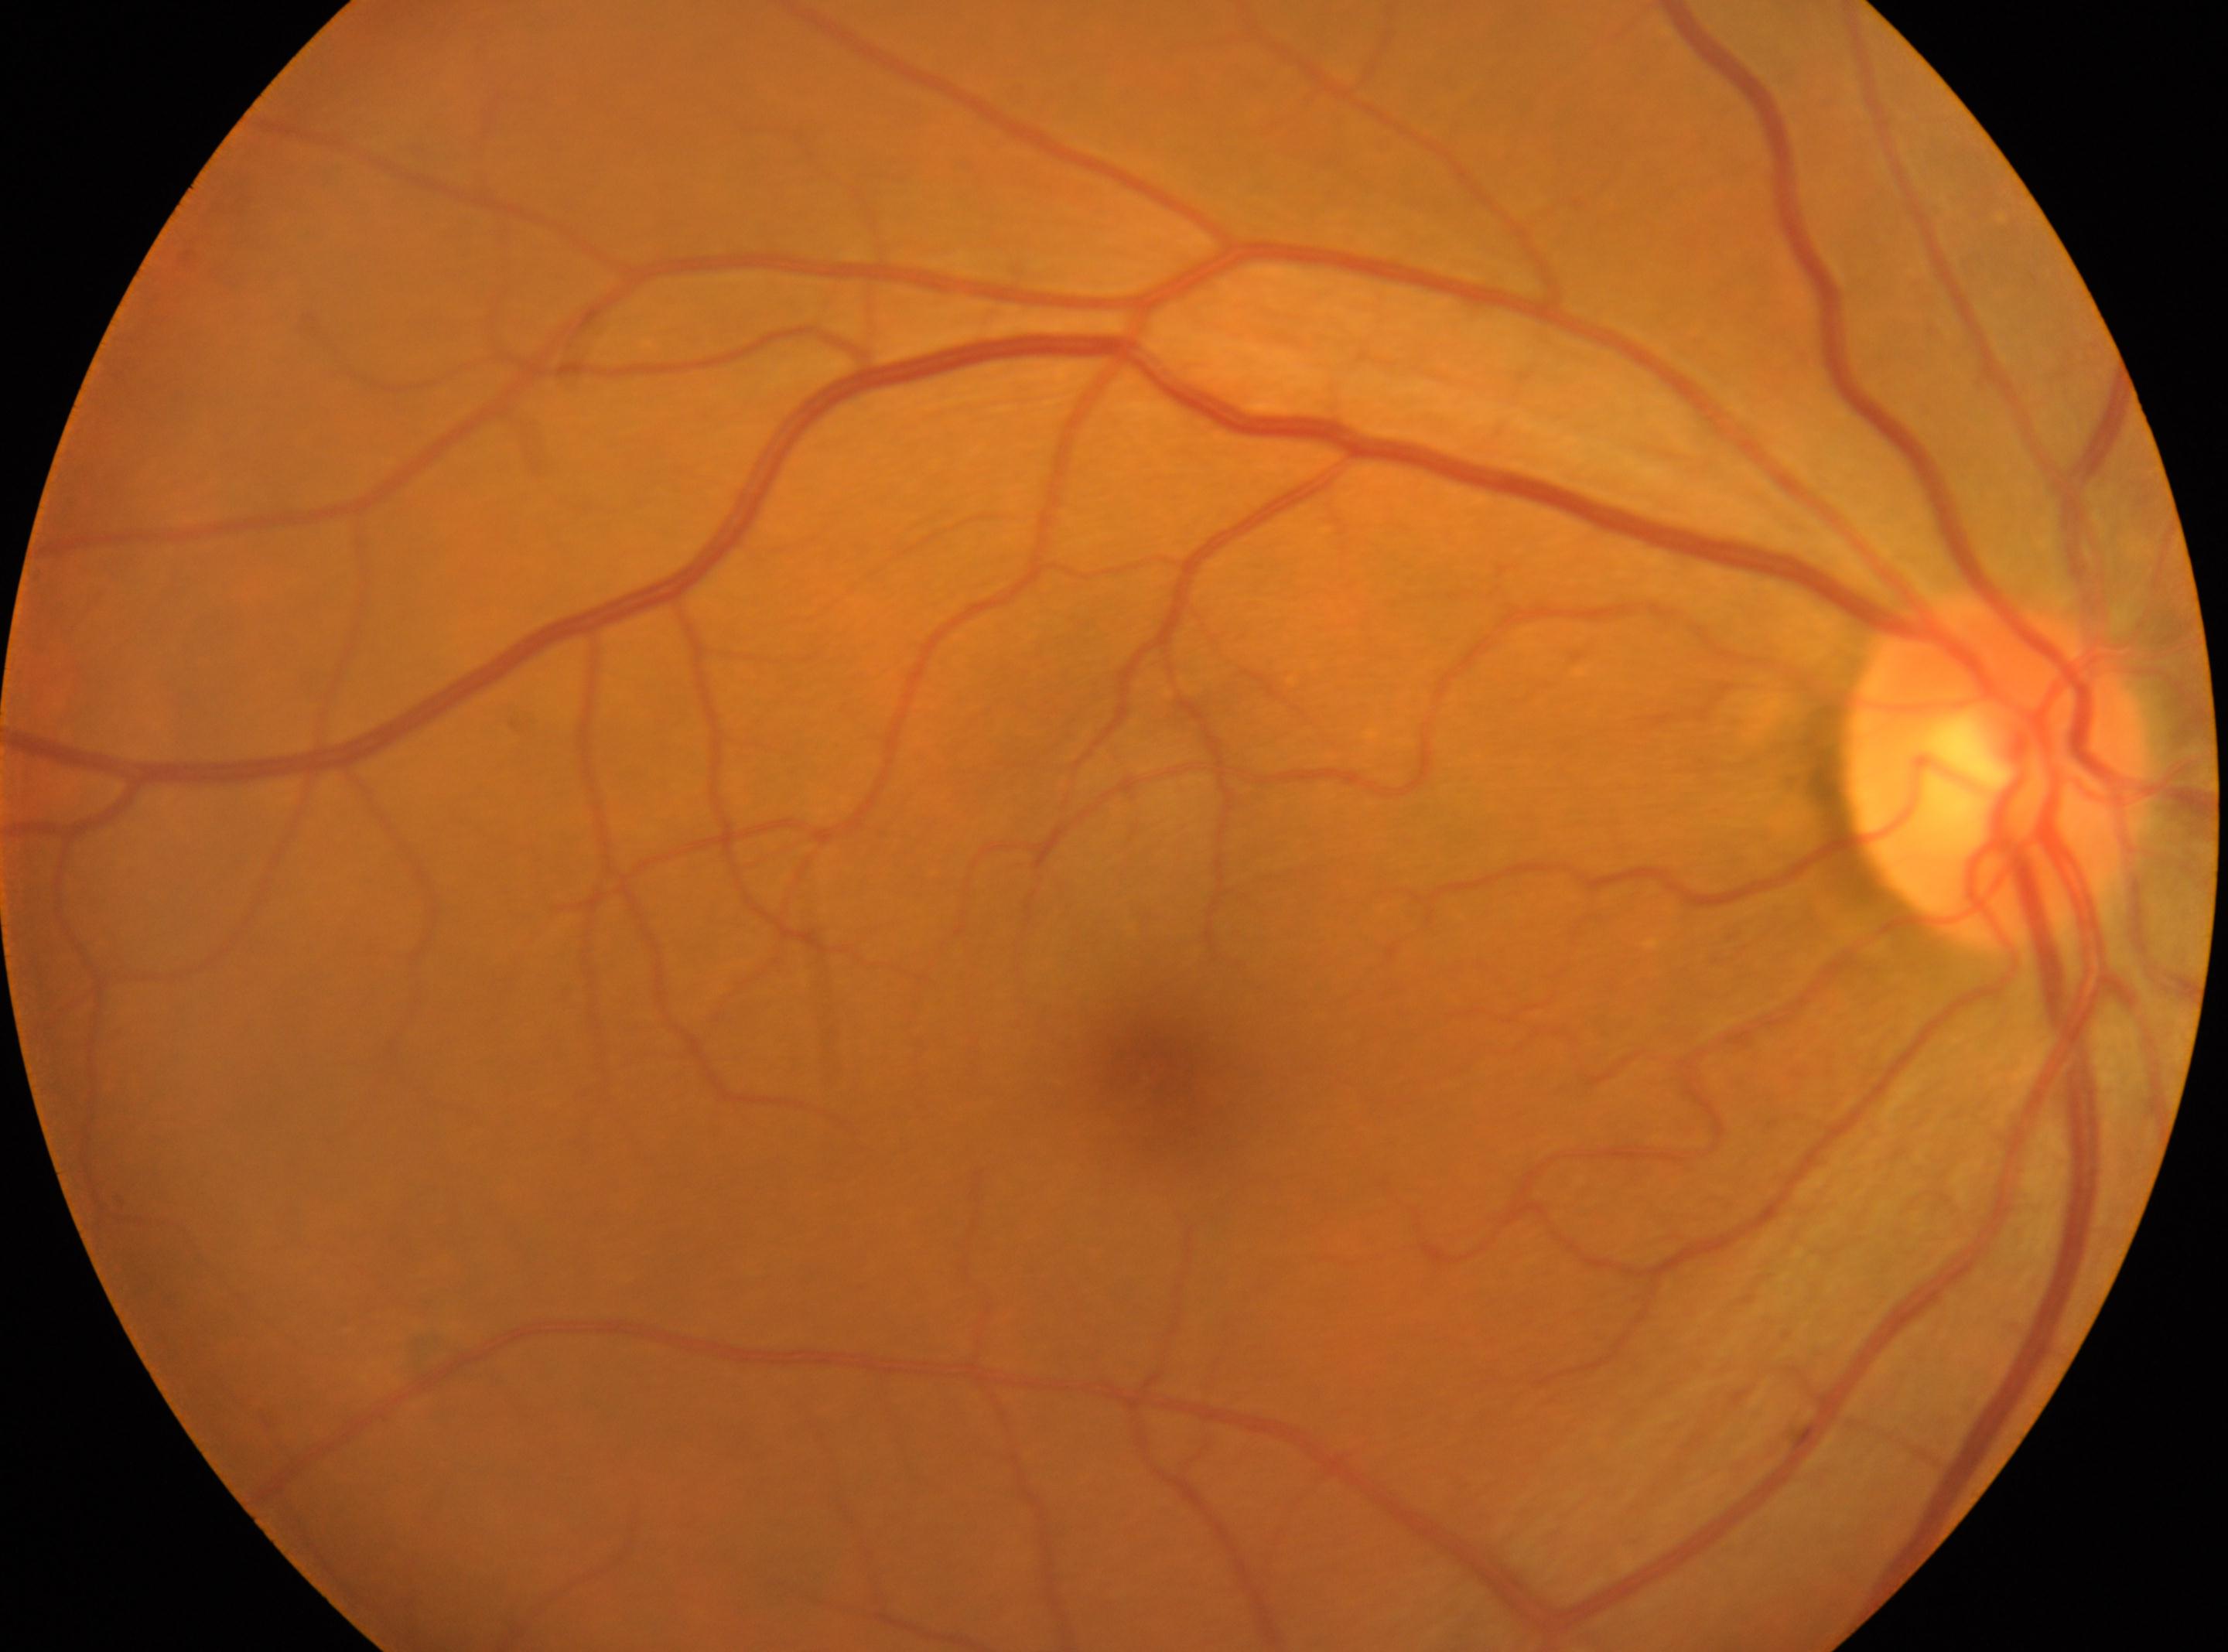

fovea: (1150,1070)
optic_disc: (1997,774)
eye: the right eye
dr_grade: 0/4